NIDEK AFC-230 · color fundus photograph · 848x848px: 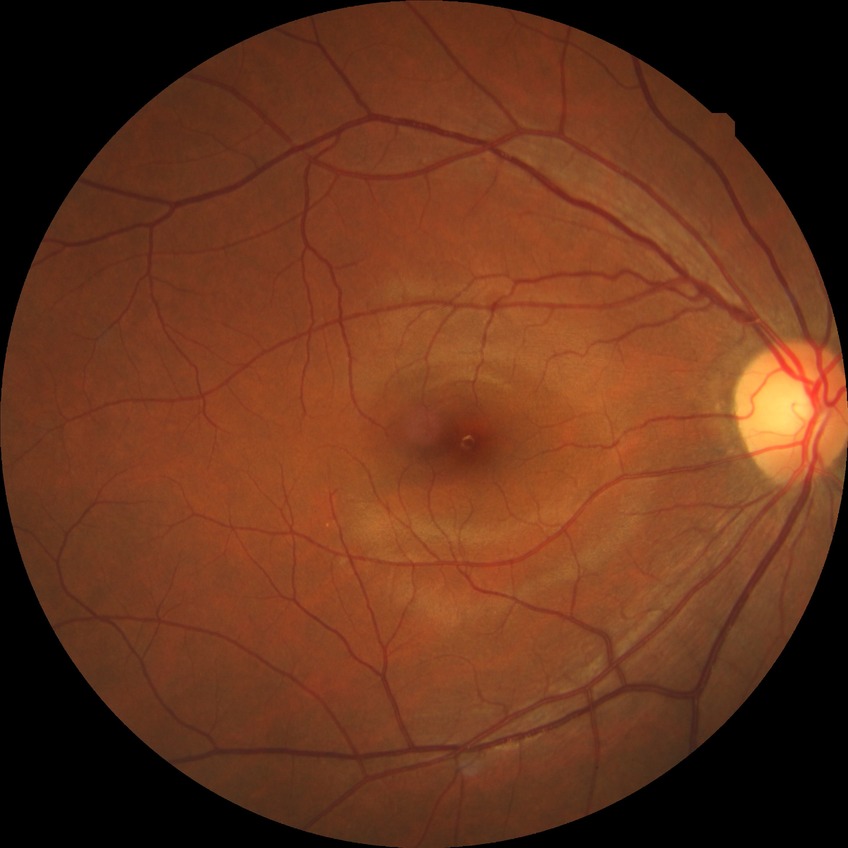 Diabetic retinopathy (DR) is no diabetic retinopathy (NDR).